FOV: 50 degrees, tabletop color fundus camera image: 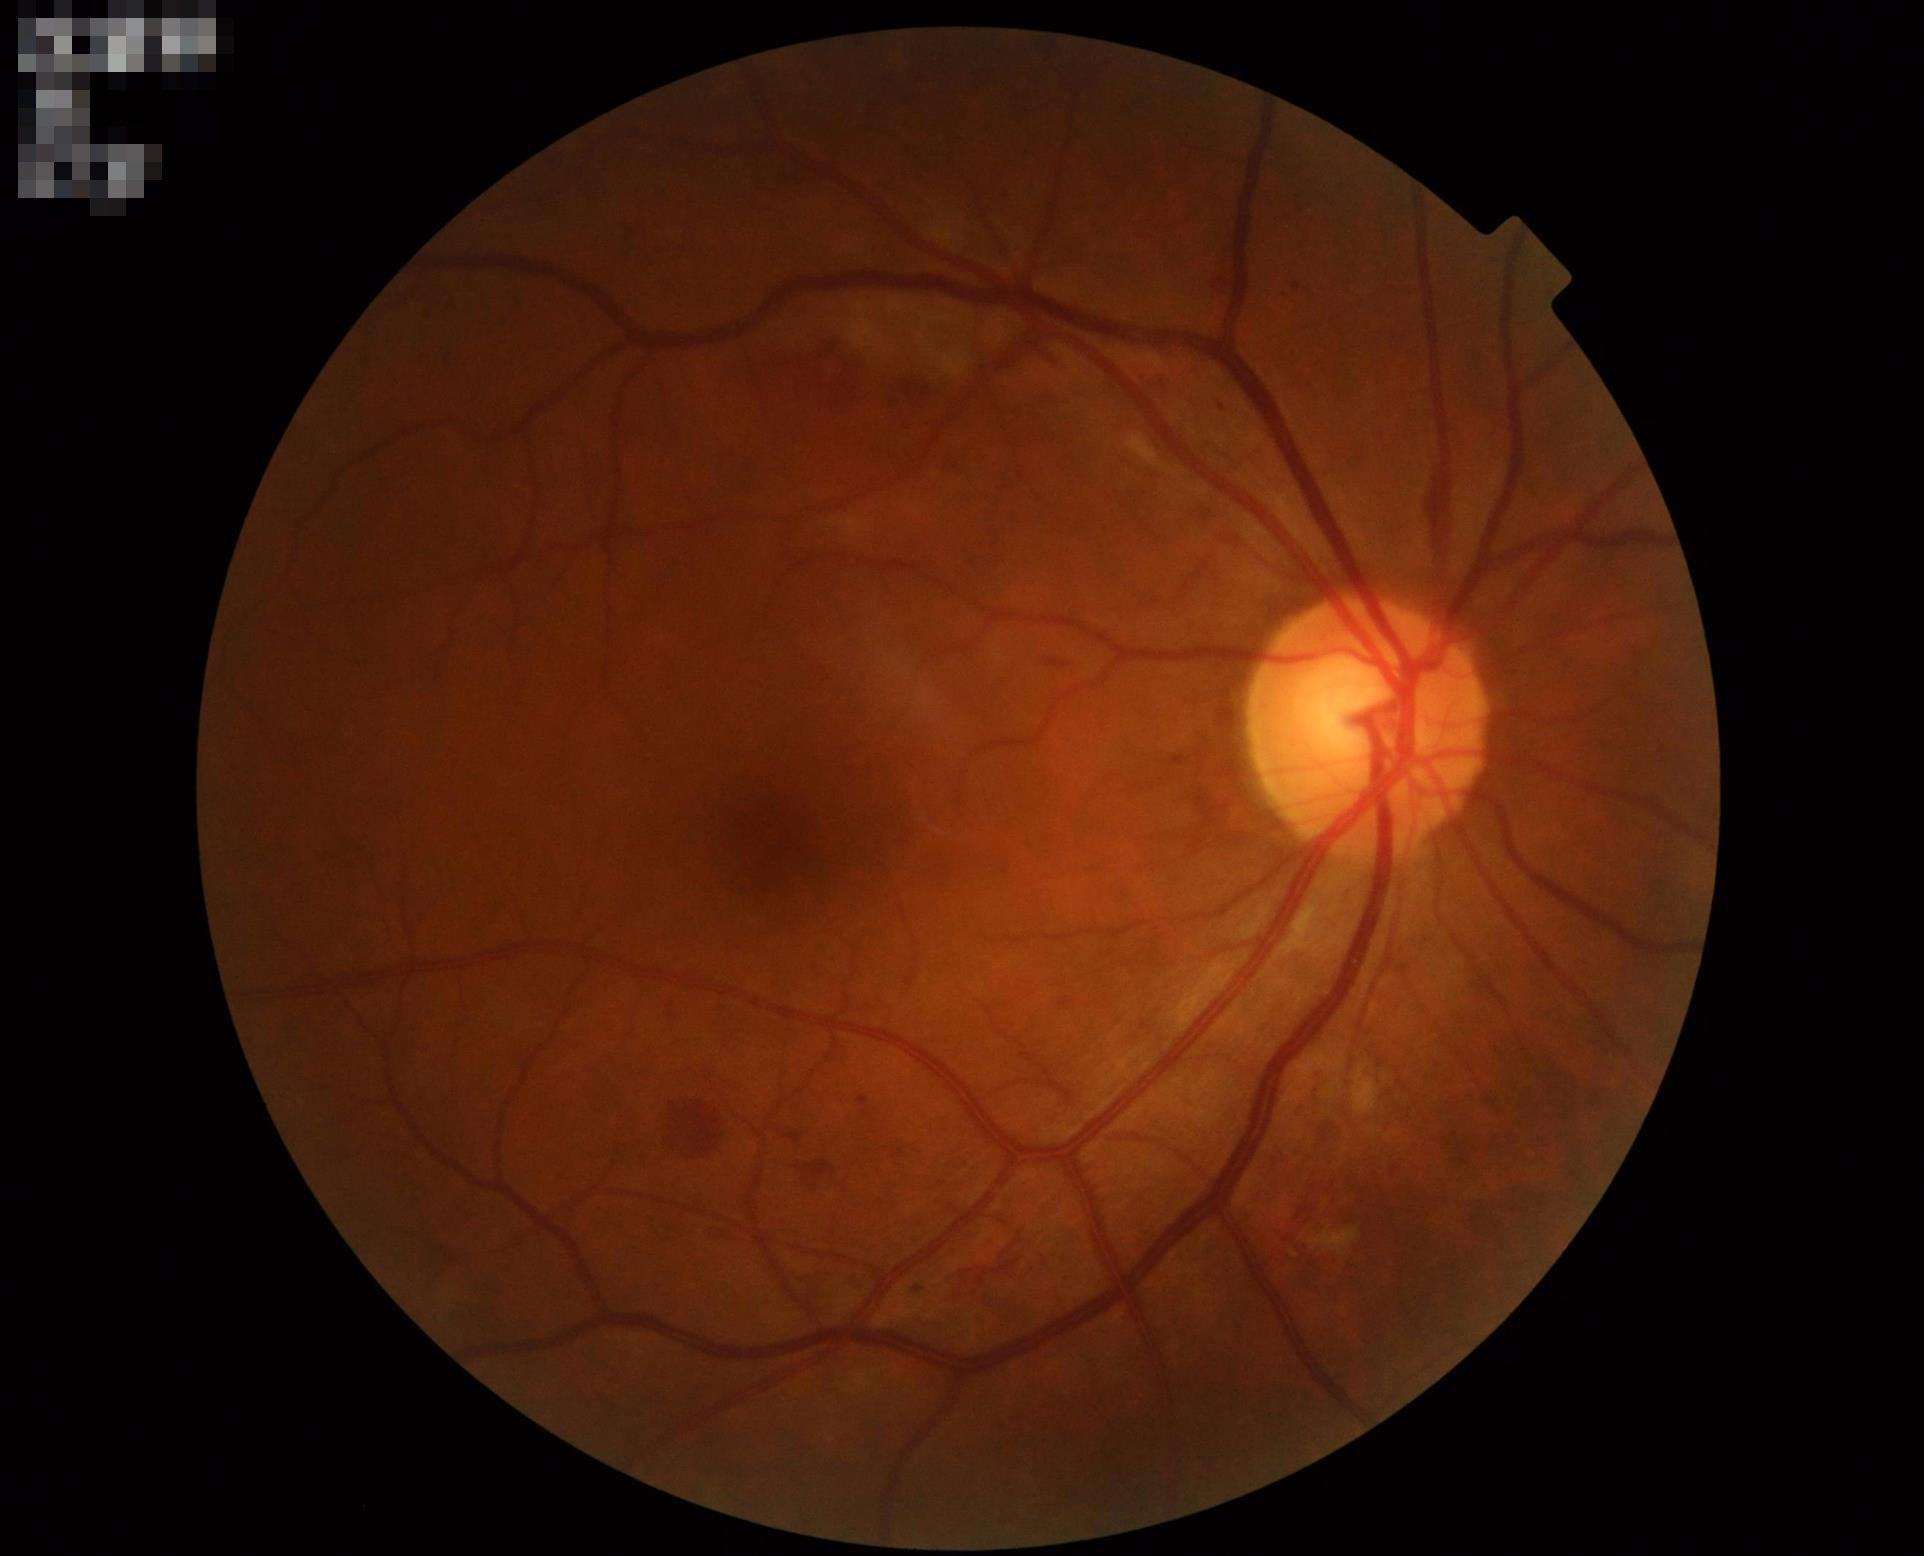 Vessels and details are readily distinguishable. Optic disc, vessels, and background are in focus. Illumination is even. Image quality is adequate for diagnostic use.